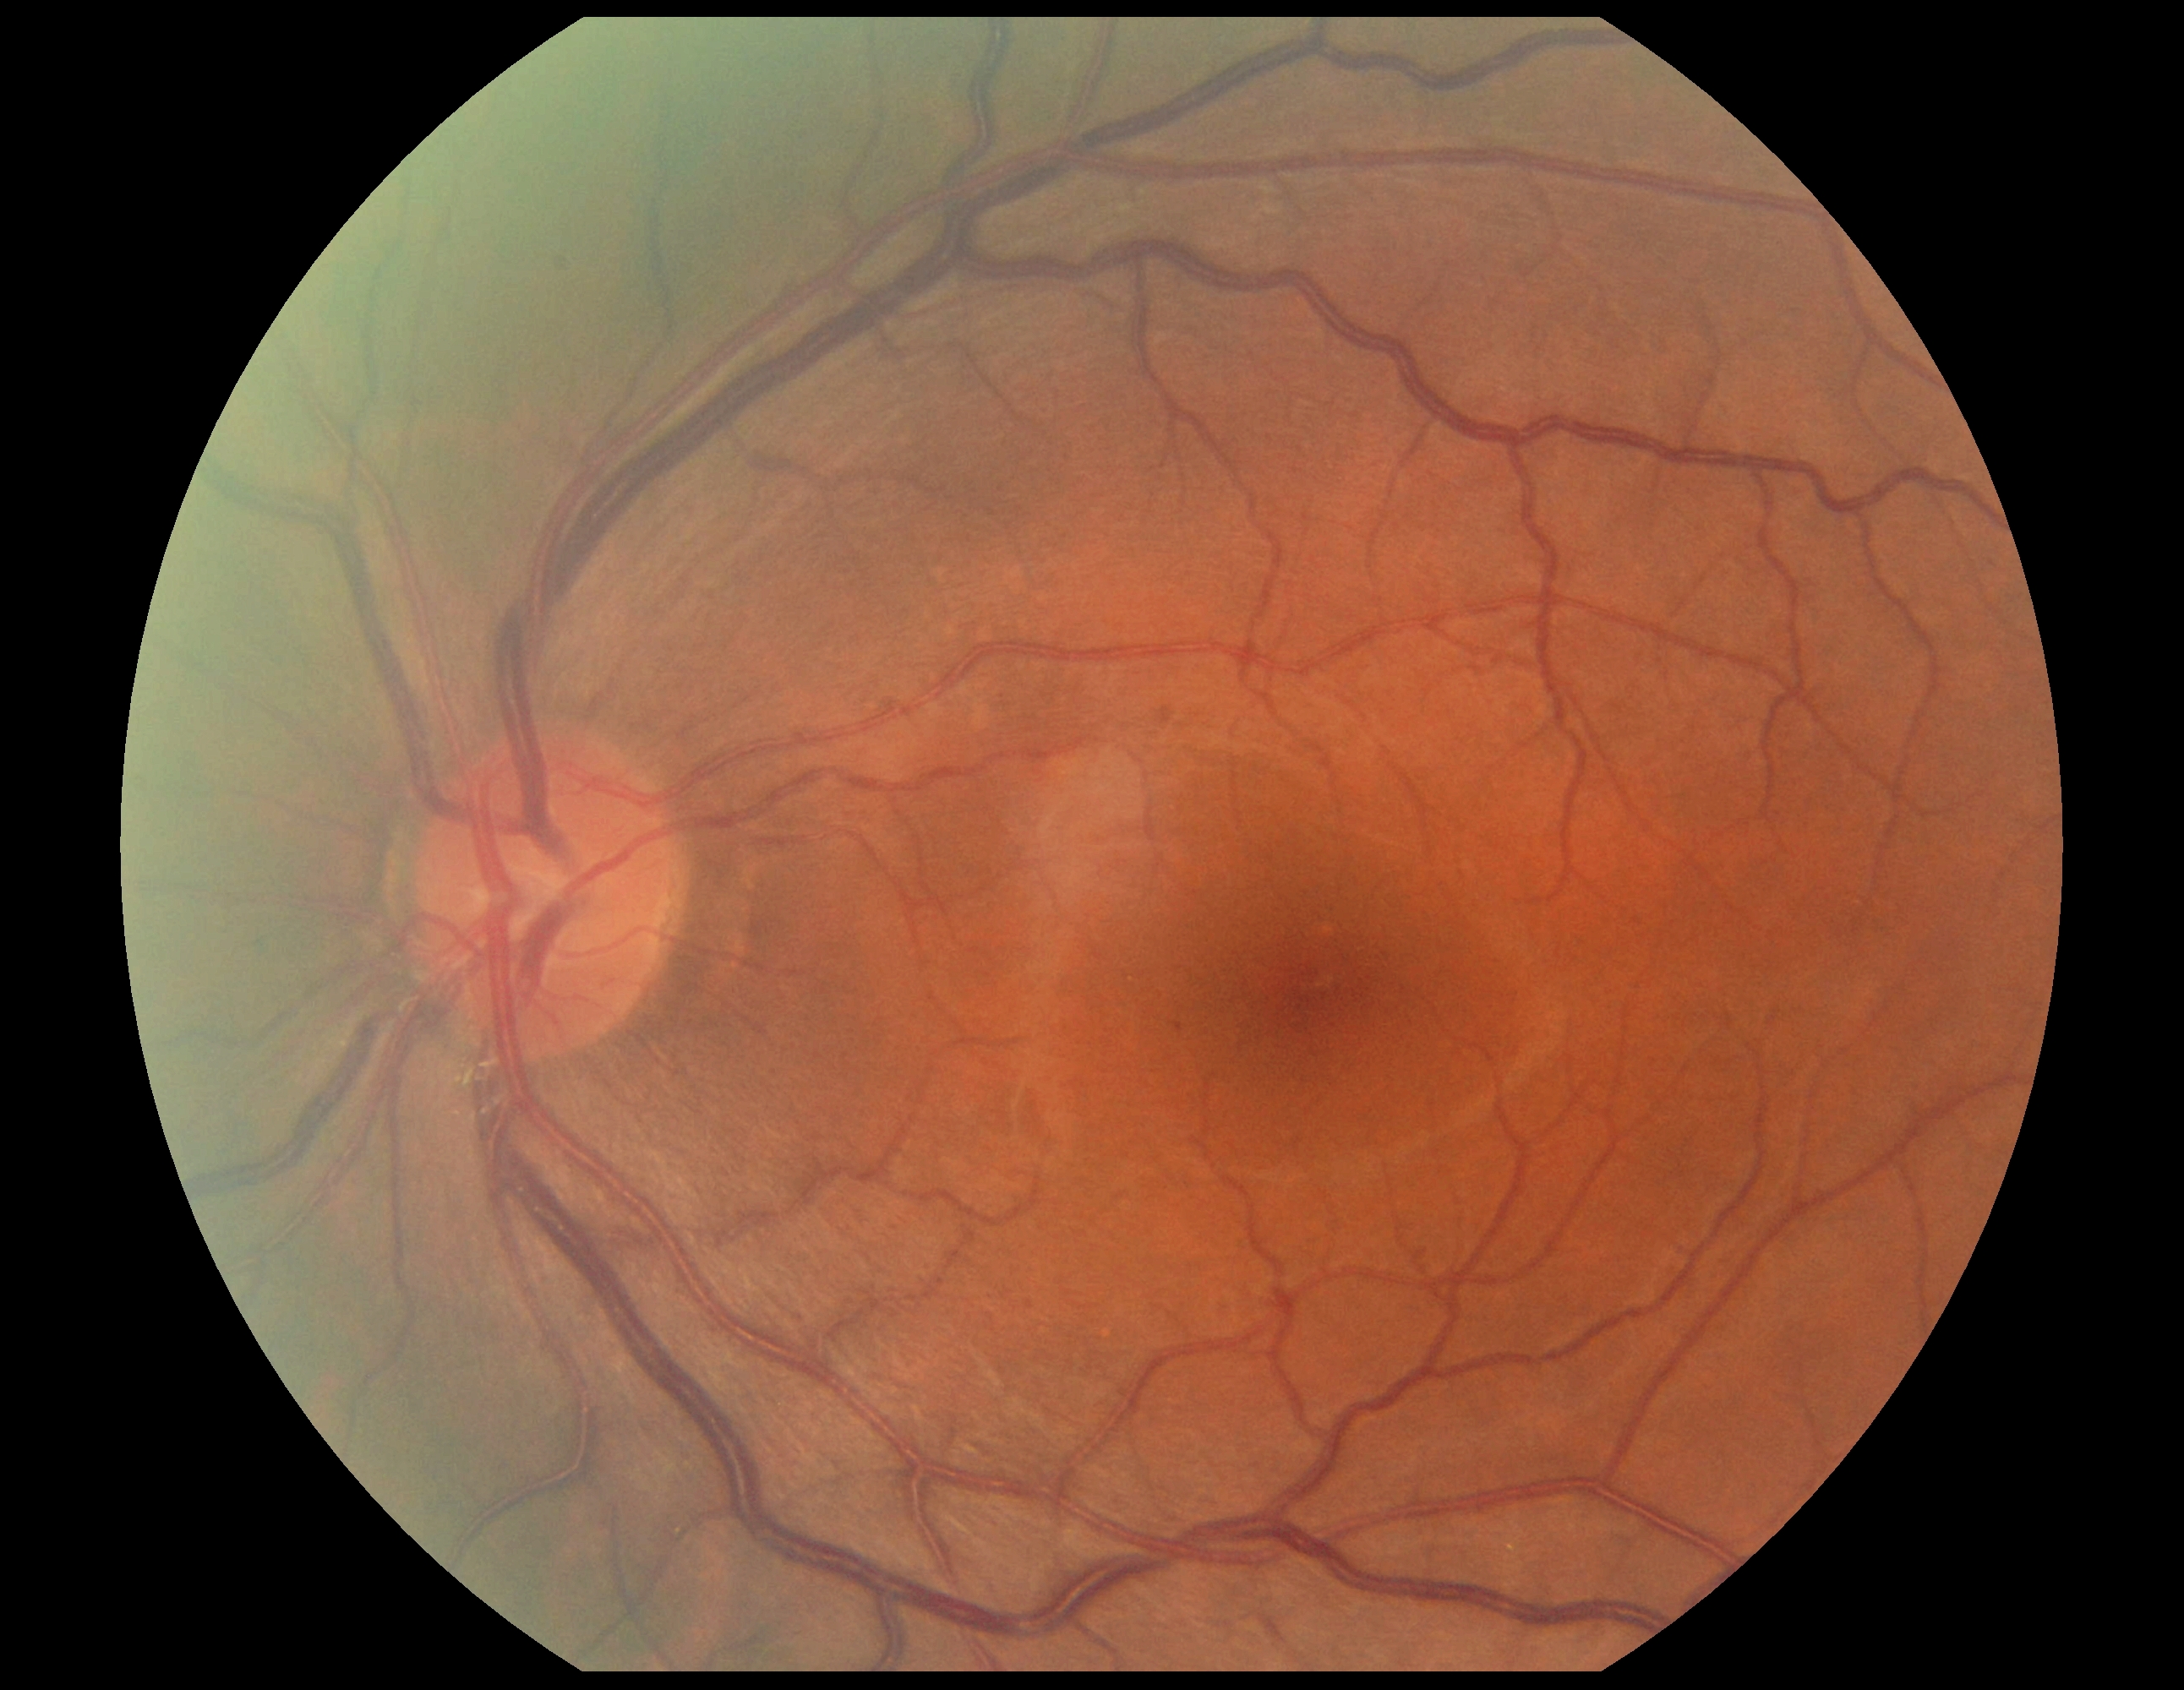 Diabetic retinopathy grade is 1.